640 by 480 pixels; acquired on the Clarity RetCam 3; wide-field contact fundus photograph of an infant.
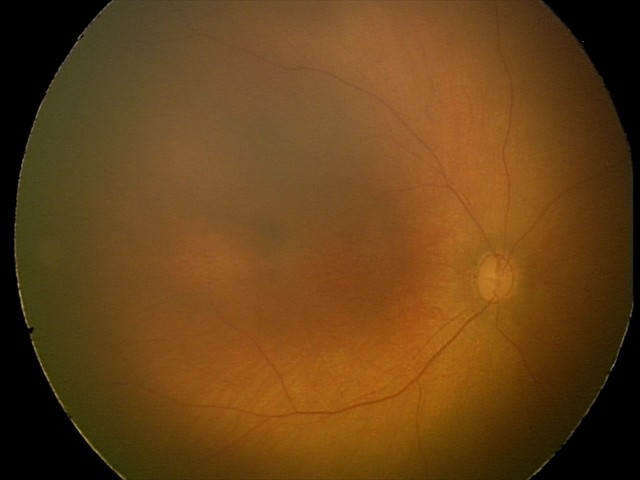

Impression: physiological finding.